848x848px
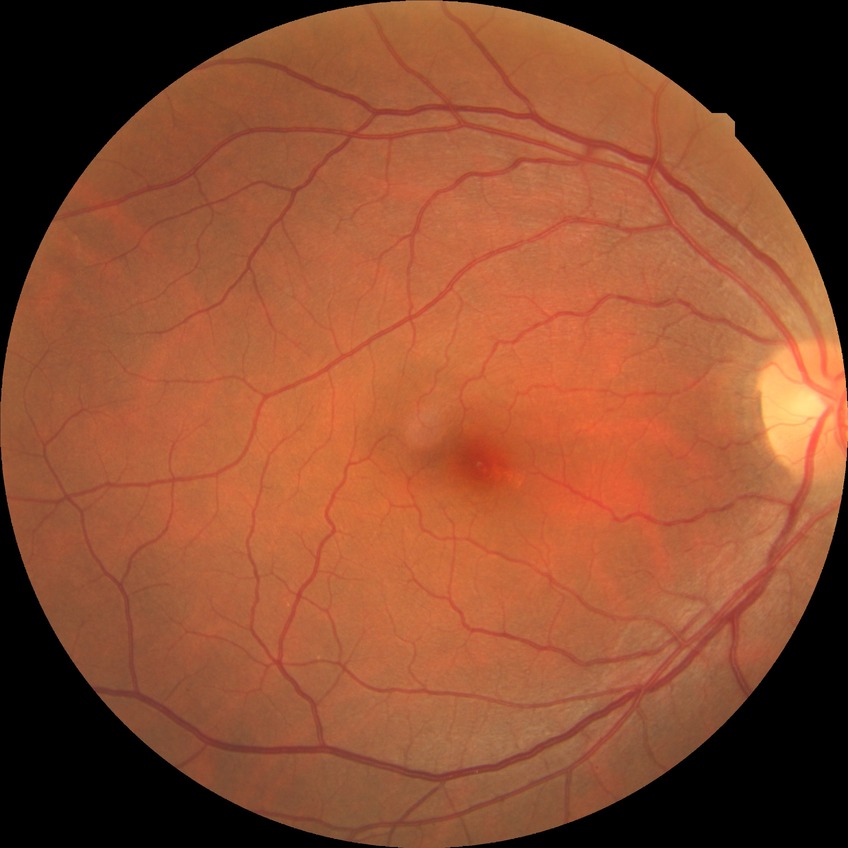 modified Davis grading = no diabetic retinopathy.